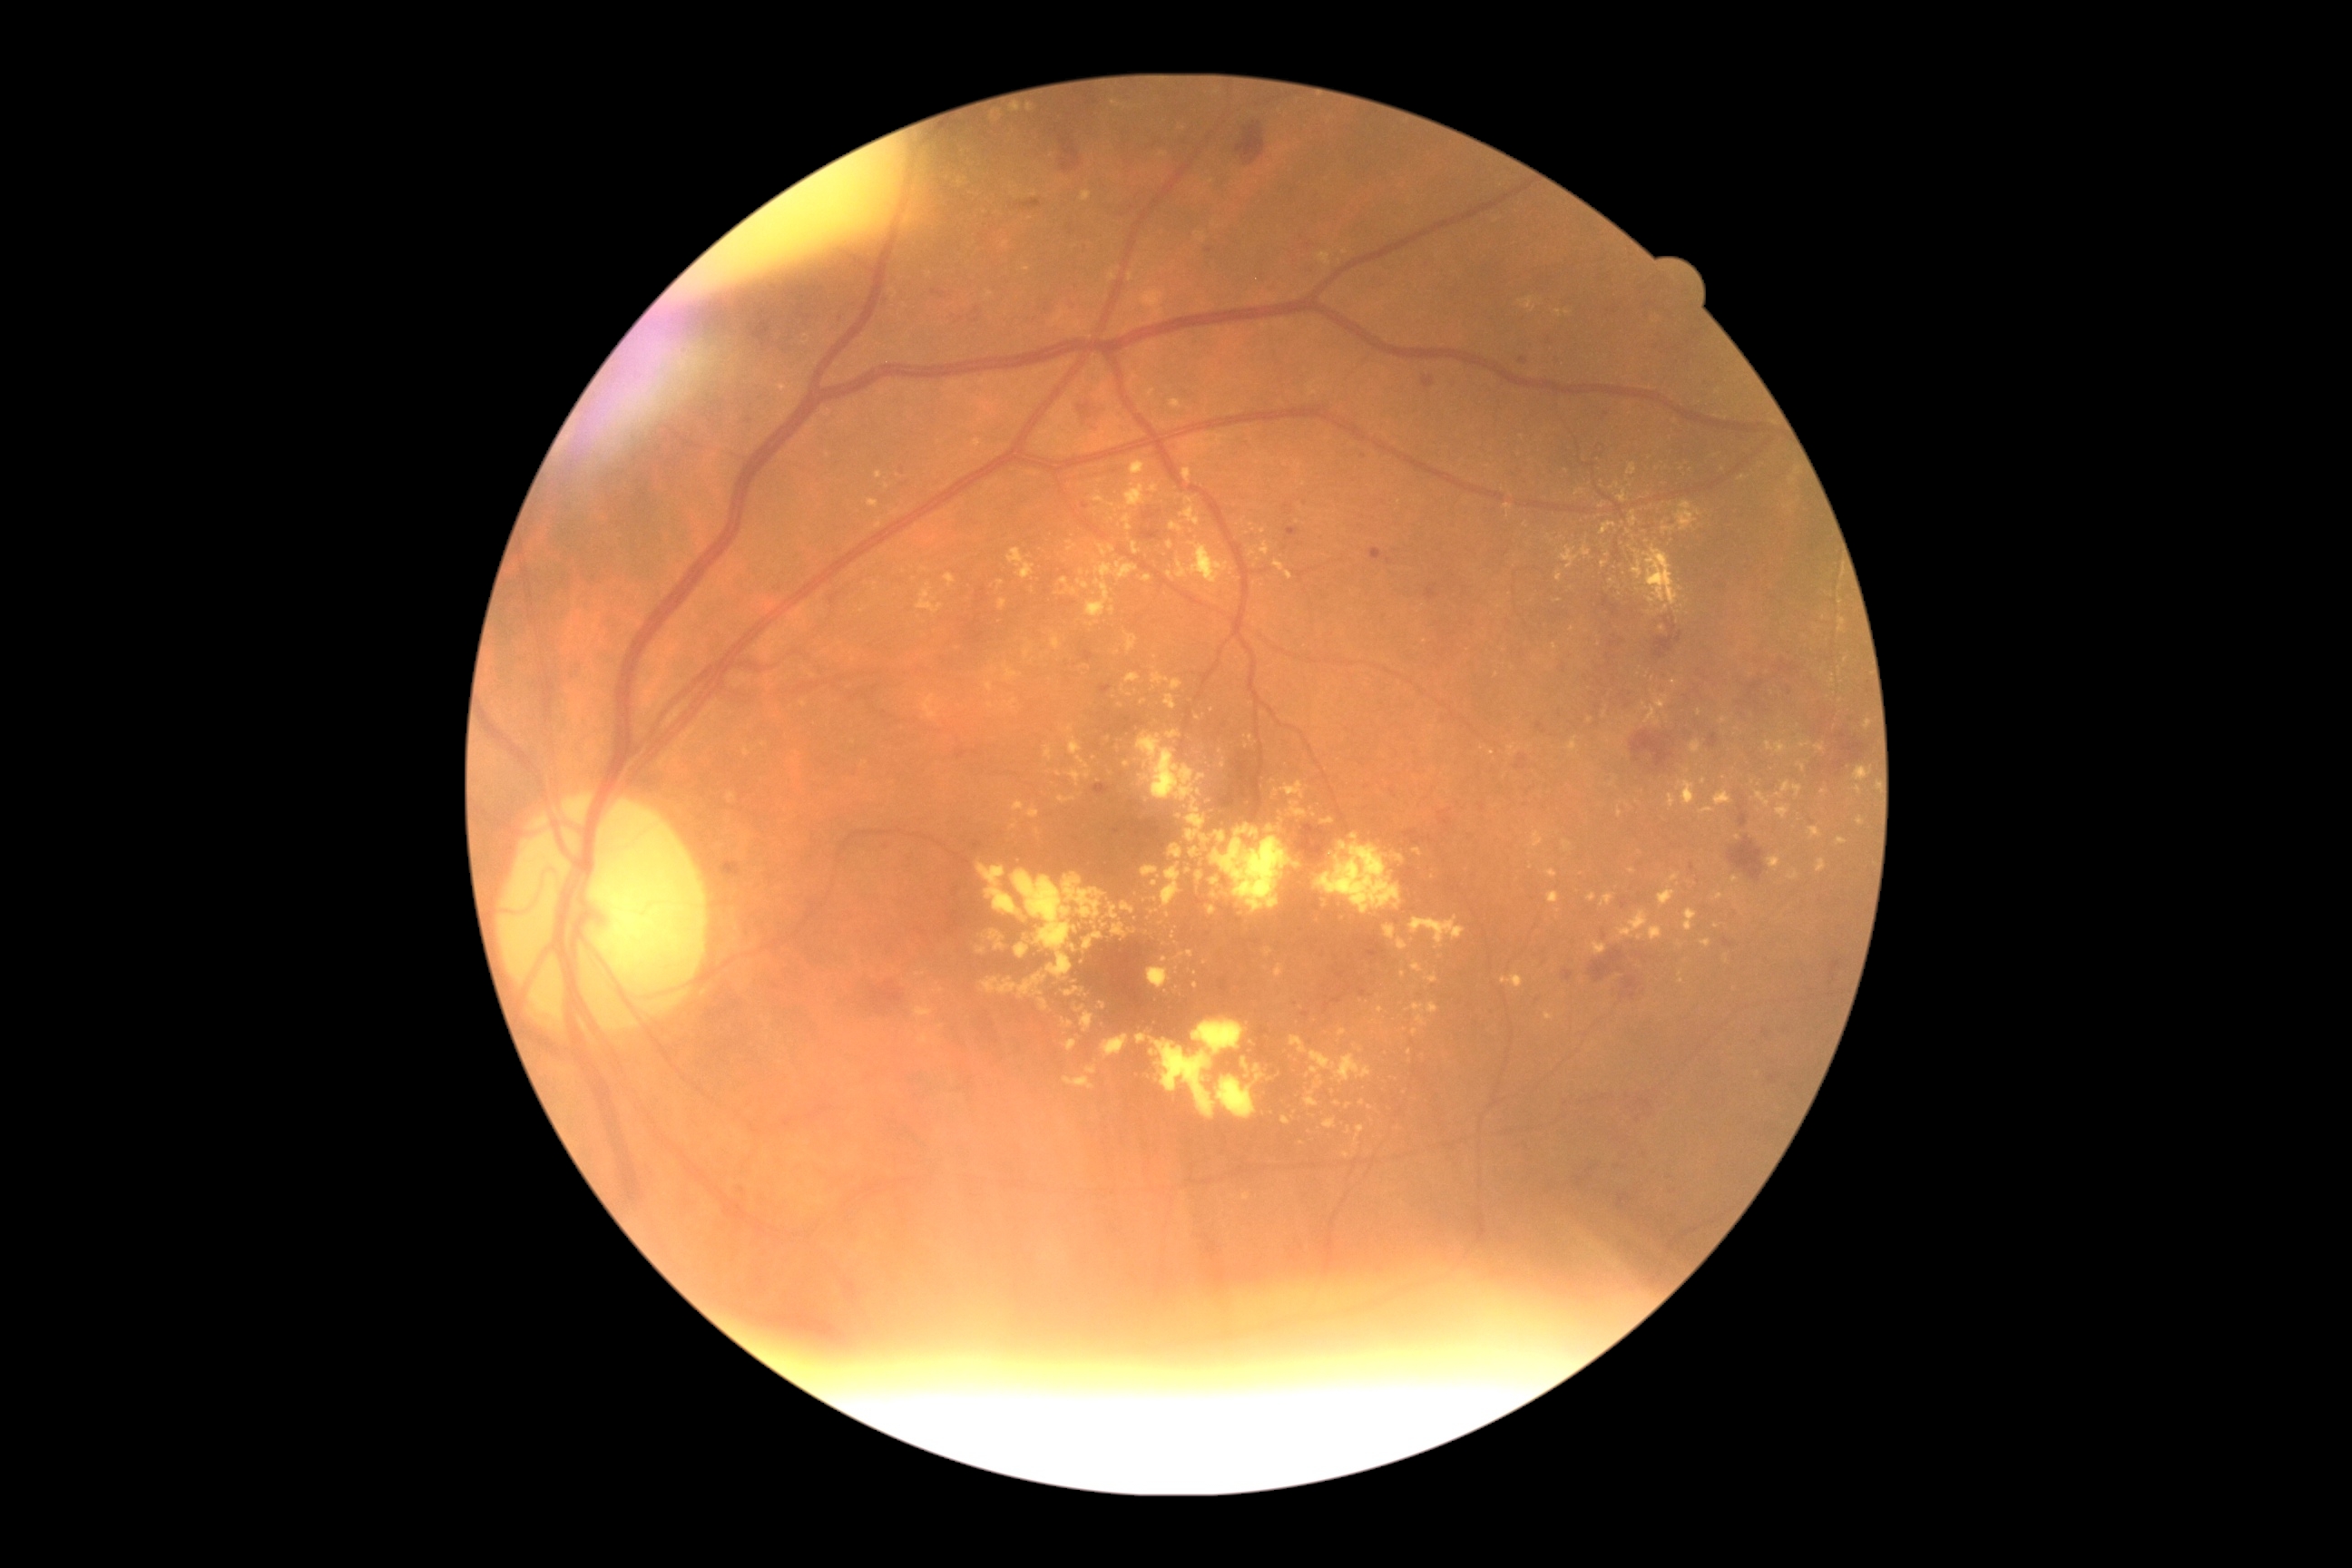

Diabetic retinopathy (DR) is 2
Representative lesions:
hard exudates (EXs) (subset): left=1063, top=1019, right=1073, bottom=1028, left=1669, top=794, right=1678, bottom=808, left=977, top=863, right=1023, bottom=916, left=1014, top=801, right=1026, bottom=812, left=1576, top=489, right=1585, bottom=496, left=1589, top=943, right=1607, bottom=956, left=977, top=946, right=986, bottom=956, left=1632, top=551, right=1643, bottom=580, left=1556, top=571, right=1563, bottom=582, left=1273, top=781, right=1306, bottom=801, left=1122, top=903, right=1135, bottom=916
Small EXs near pt(941, 1026), pt(1112, 610), pt(1522, 438), pt(1824, 792), pt(804, 704), pt(1164, 155), pt(1252, 554), pt(1526, 524)